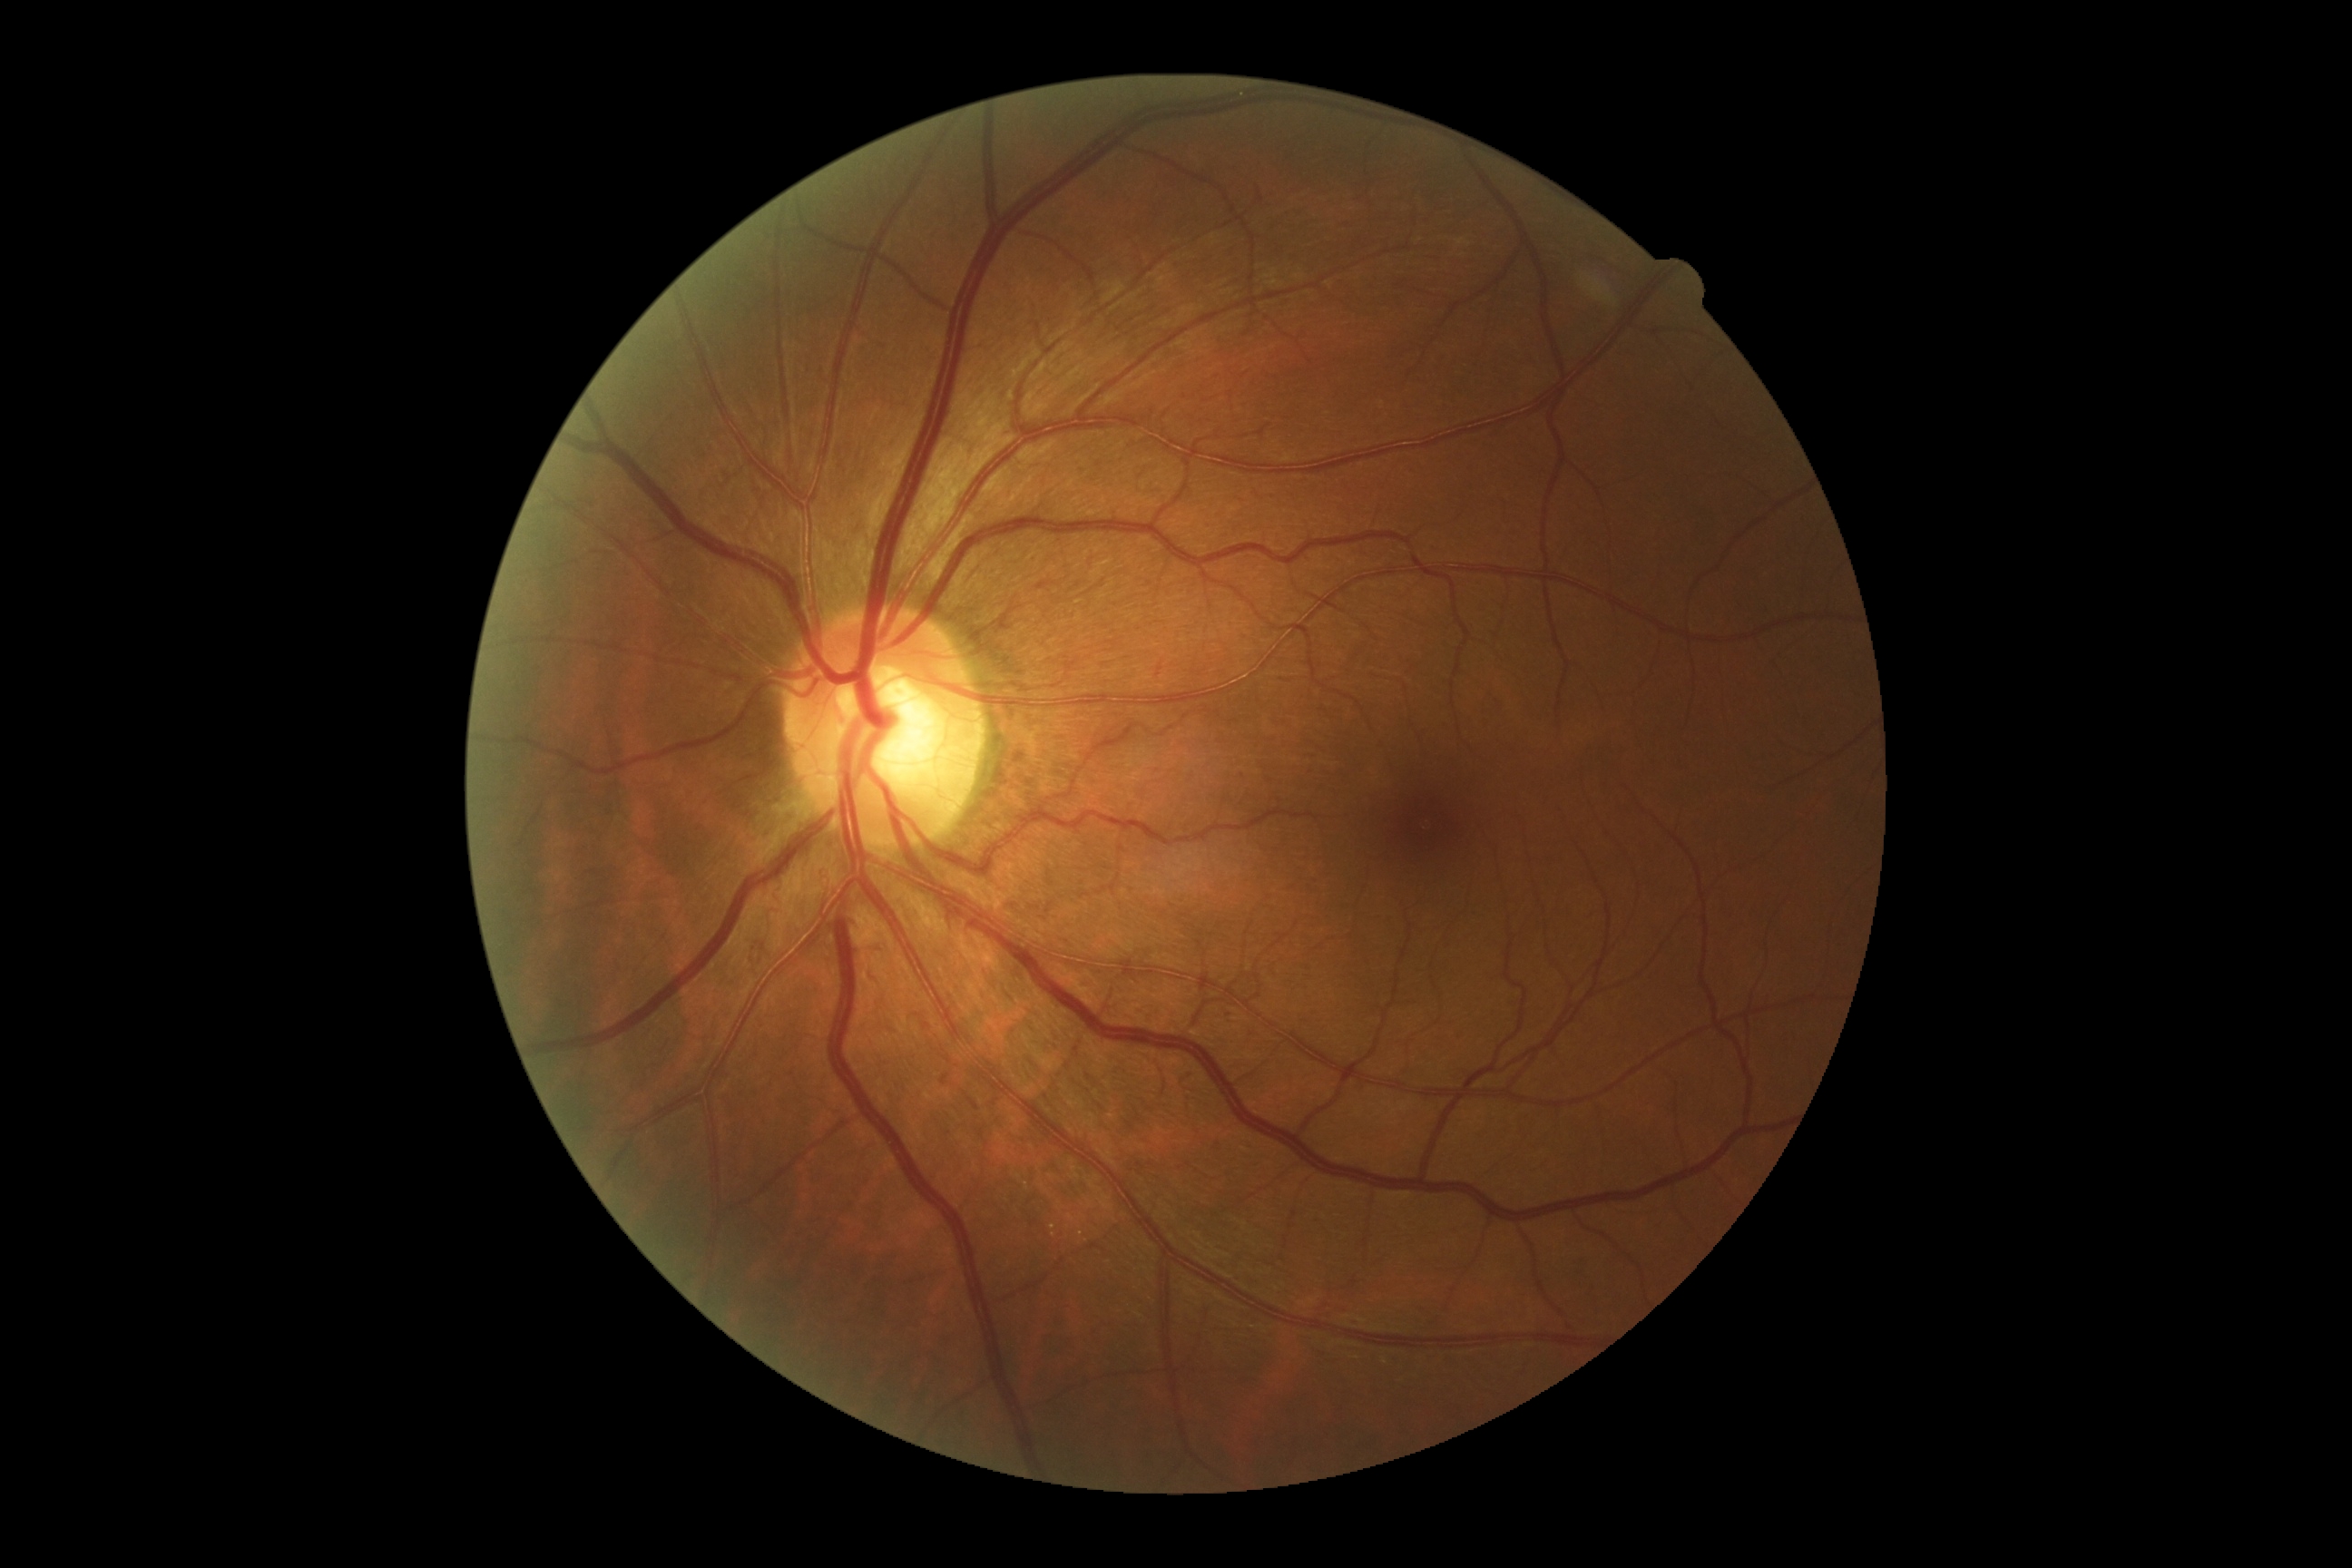

dr_grade: 0 (no apparent retinopathy)